640x480; RetCam wide-field infant fundus image: 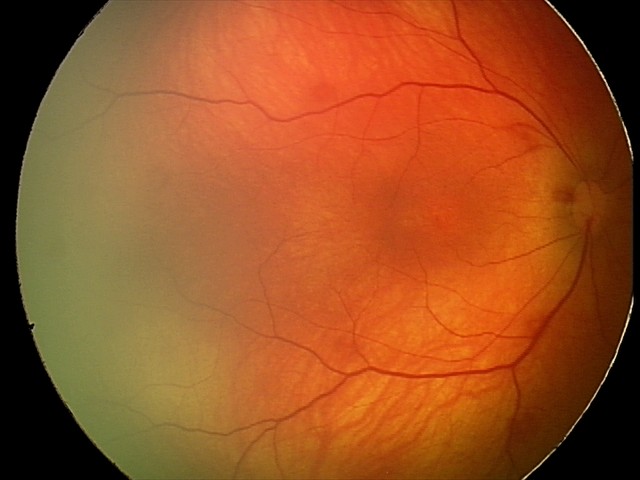 Screening diagnosis: retinal hemorrhages.